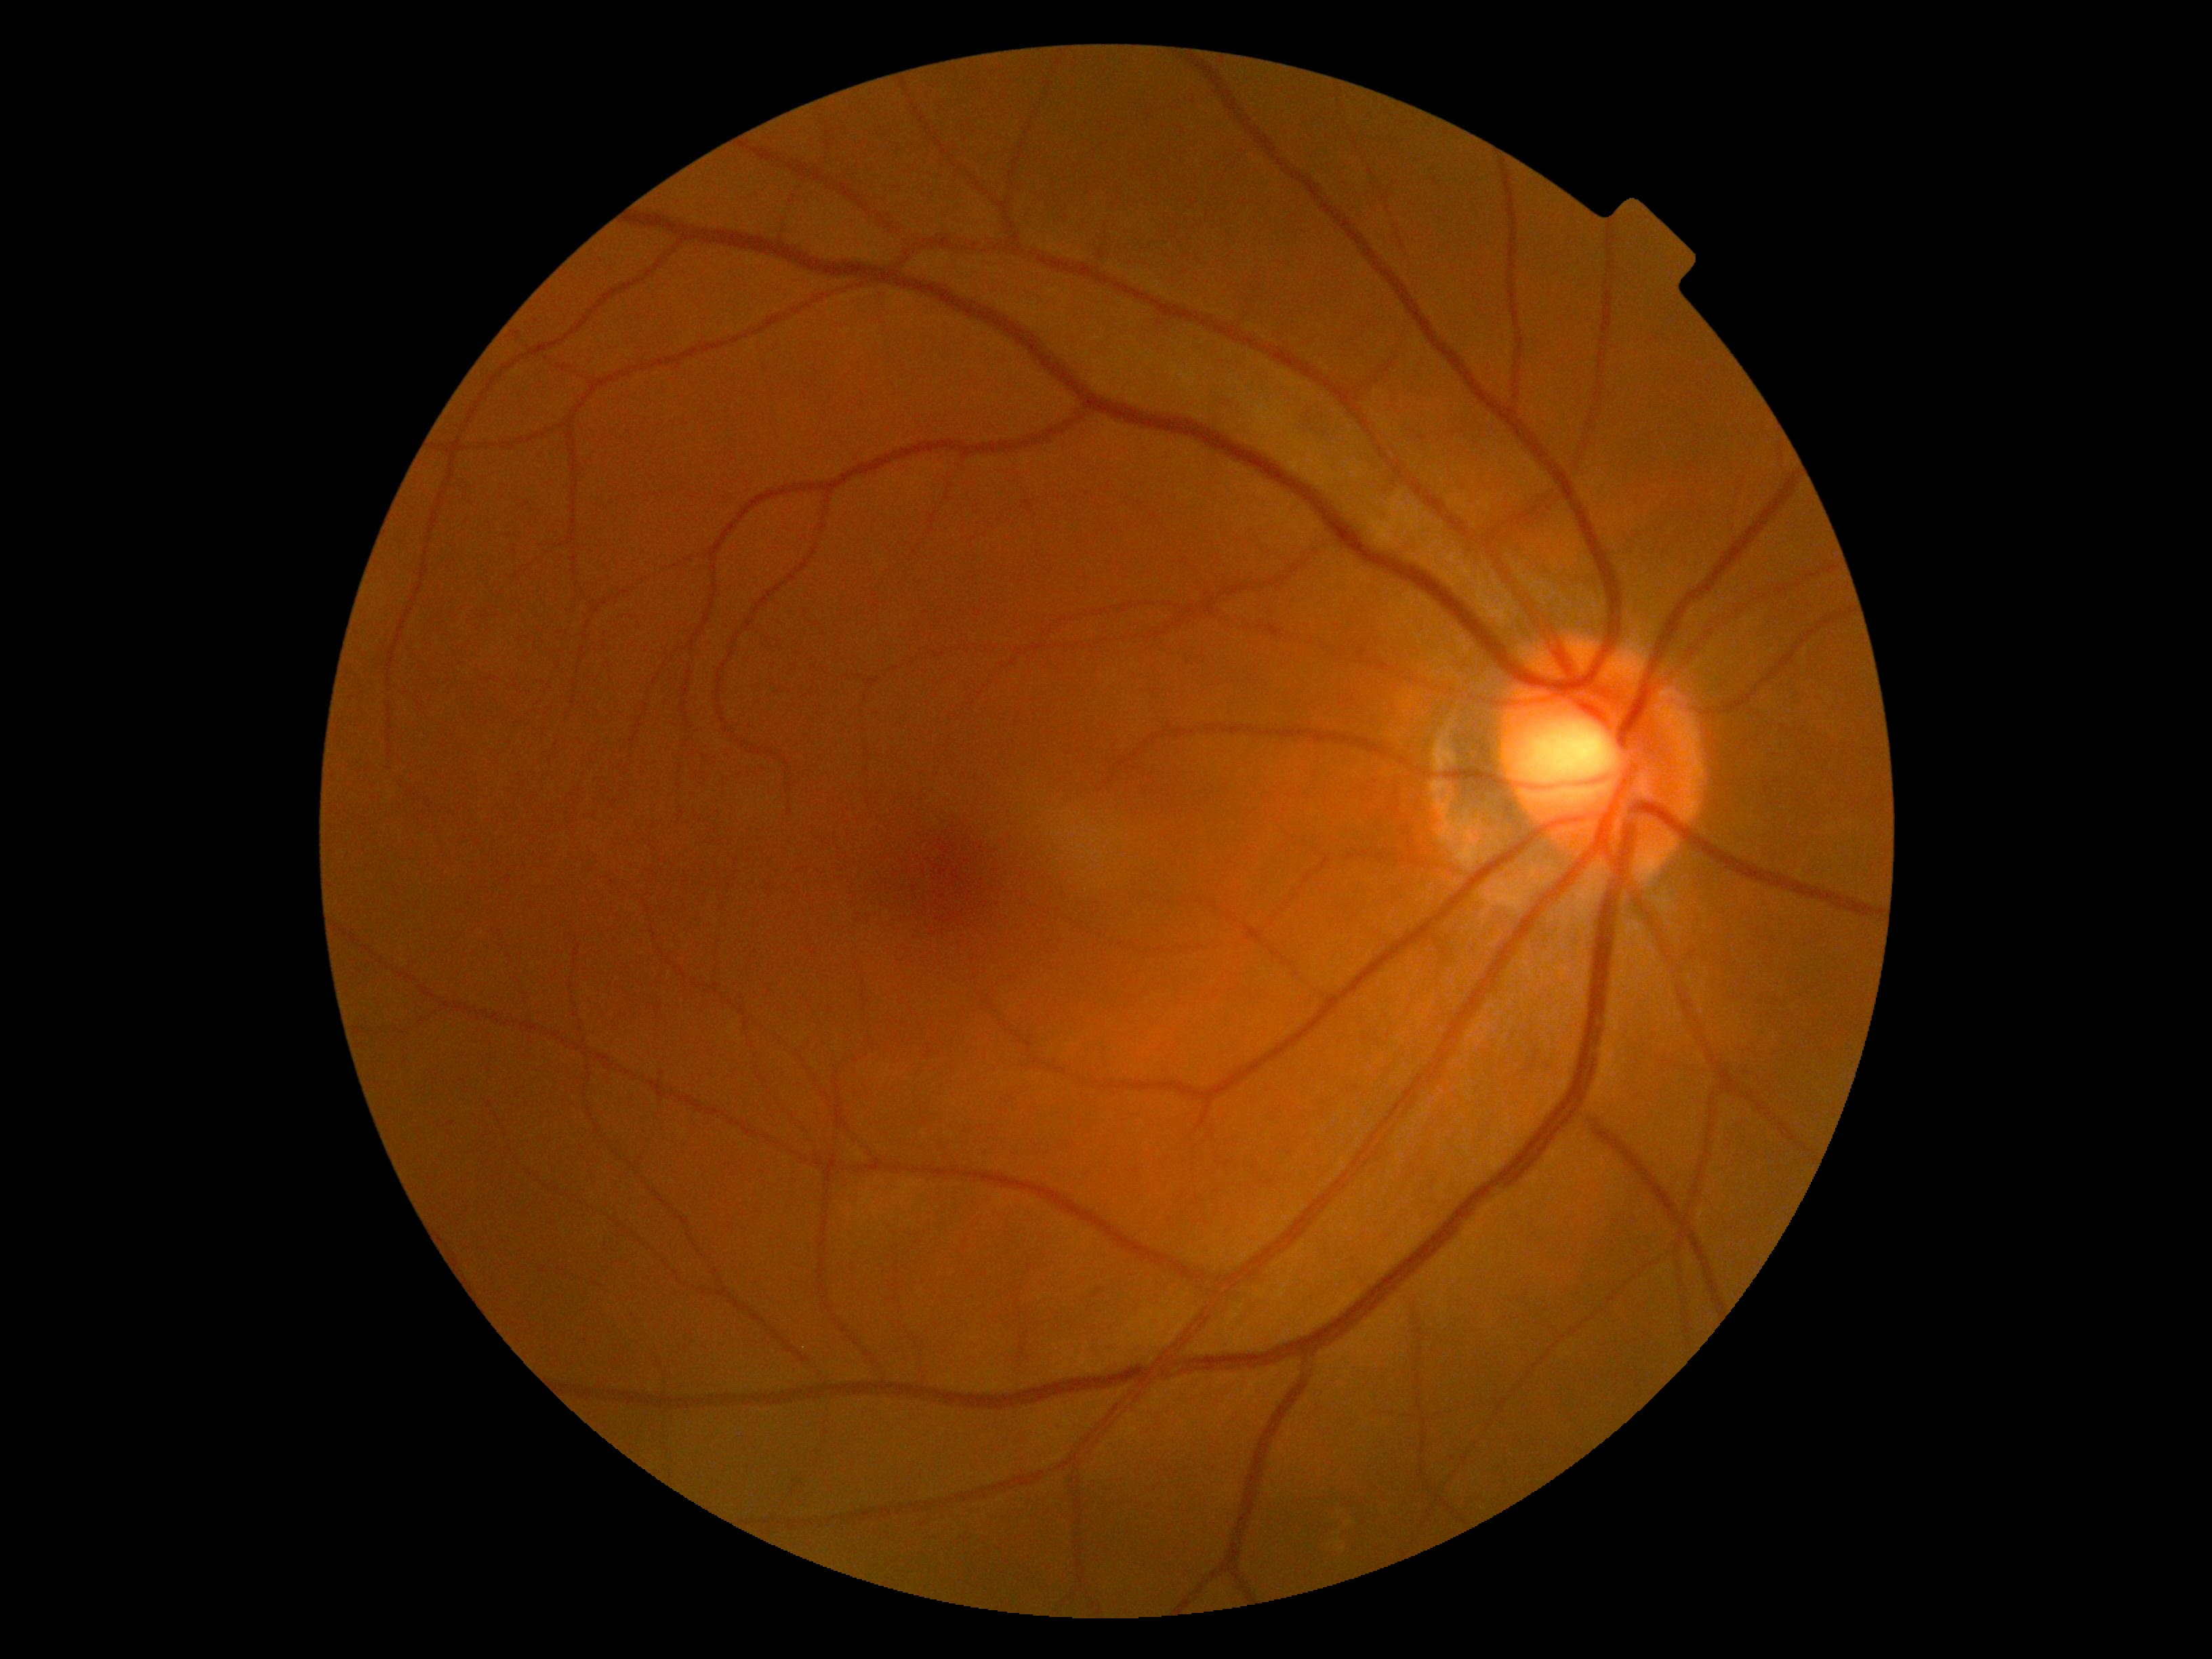
Findings:
* DR severity — 0